640x480; RetCam wide-field infant fundus image
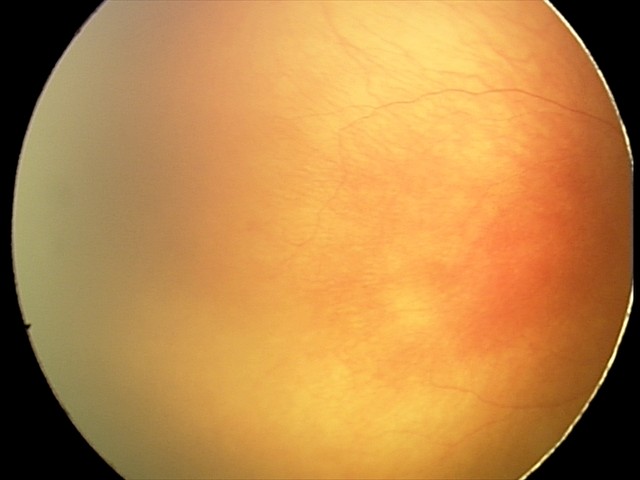
Plus form: present | impression: A-ROP (aggressive ROP).